Graded on the modified Davis scale — 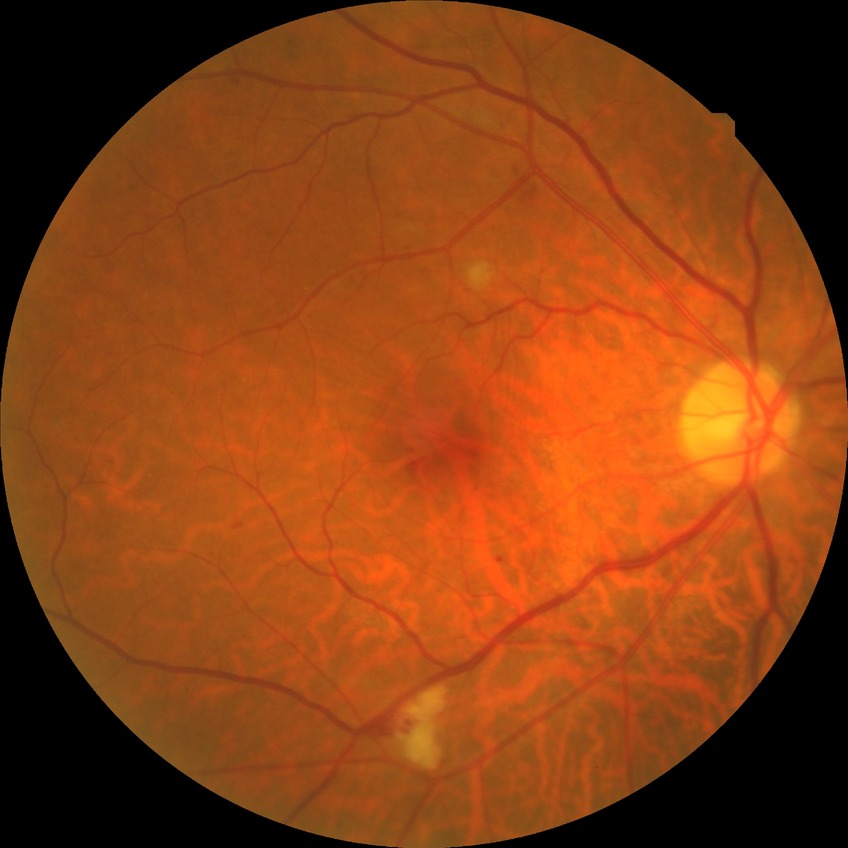
The retinopathy is classified as non-proliferative diabetic retinopathy.
Retinopathy grade: simple diabetic retinopathy.